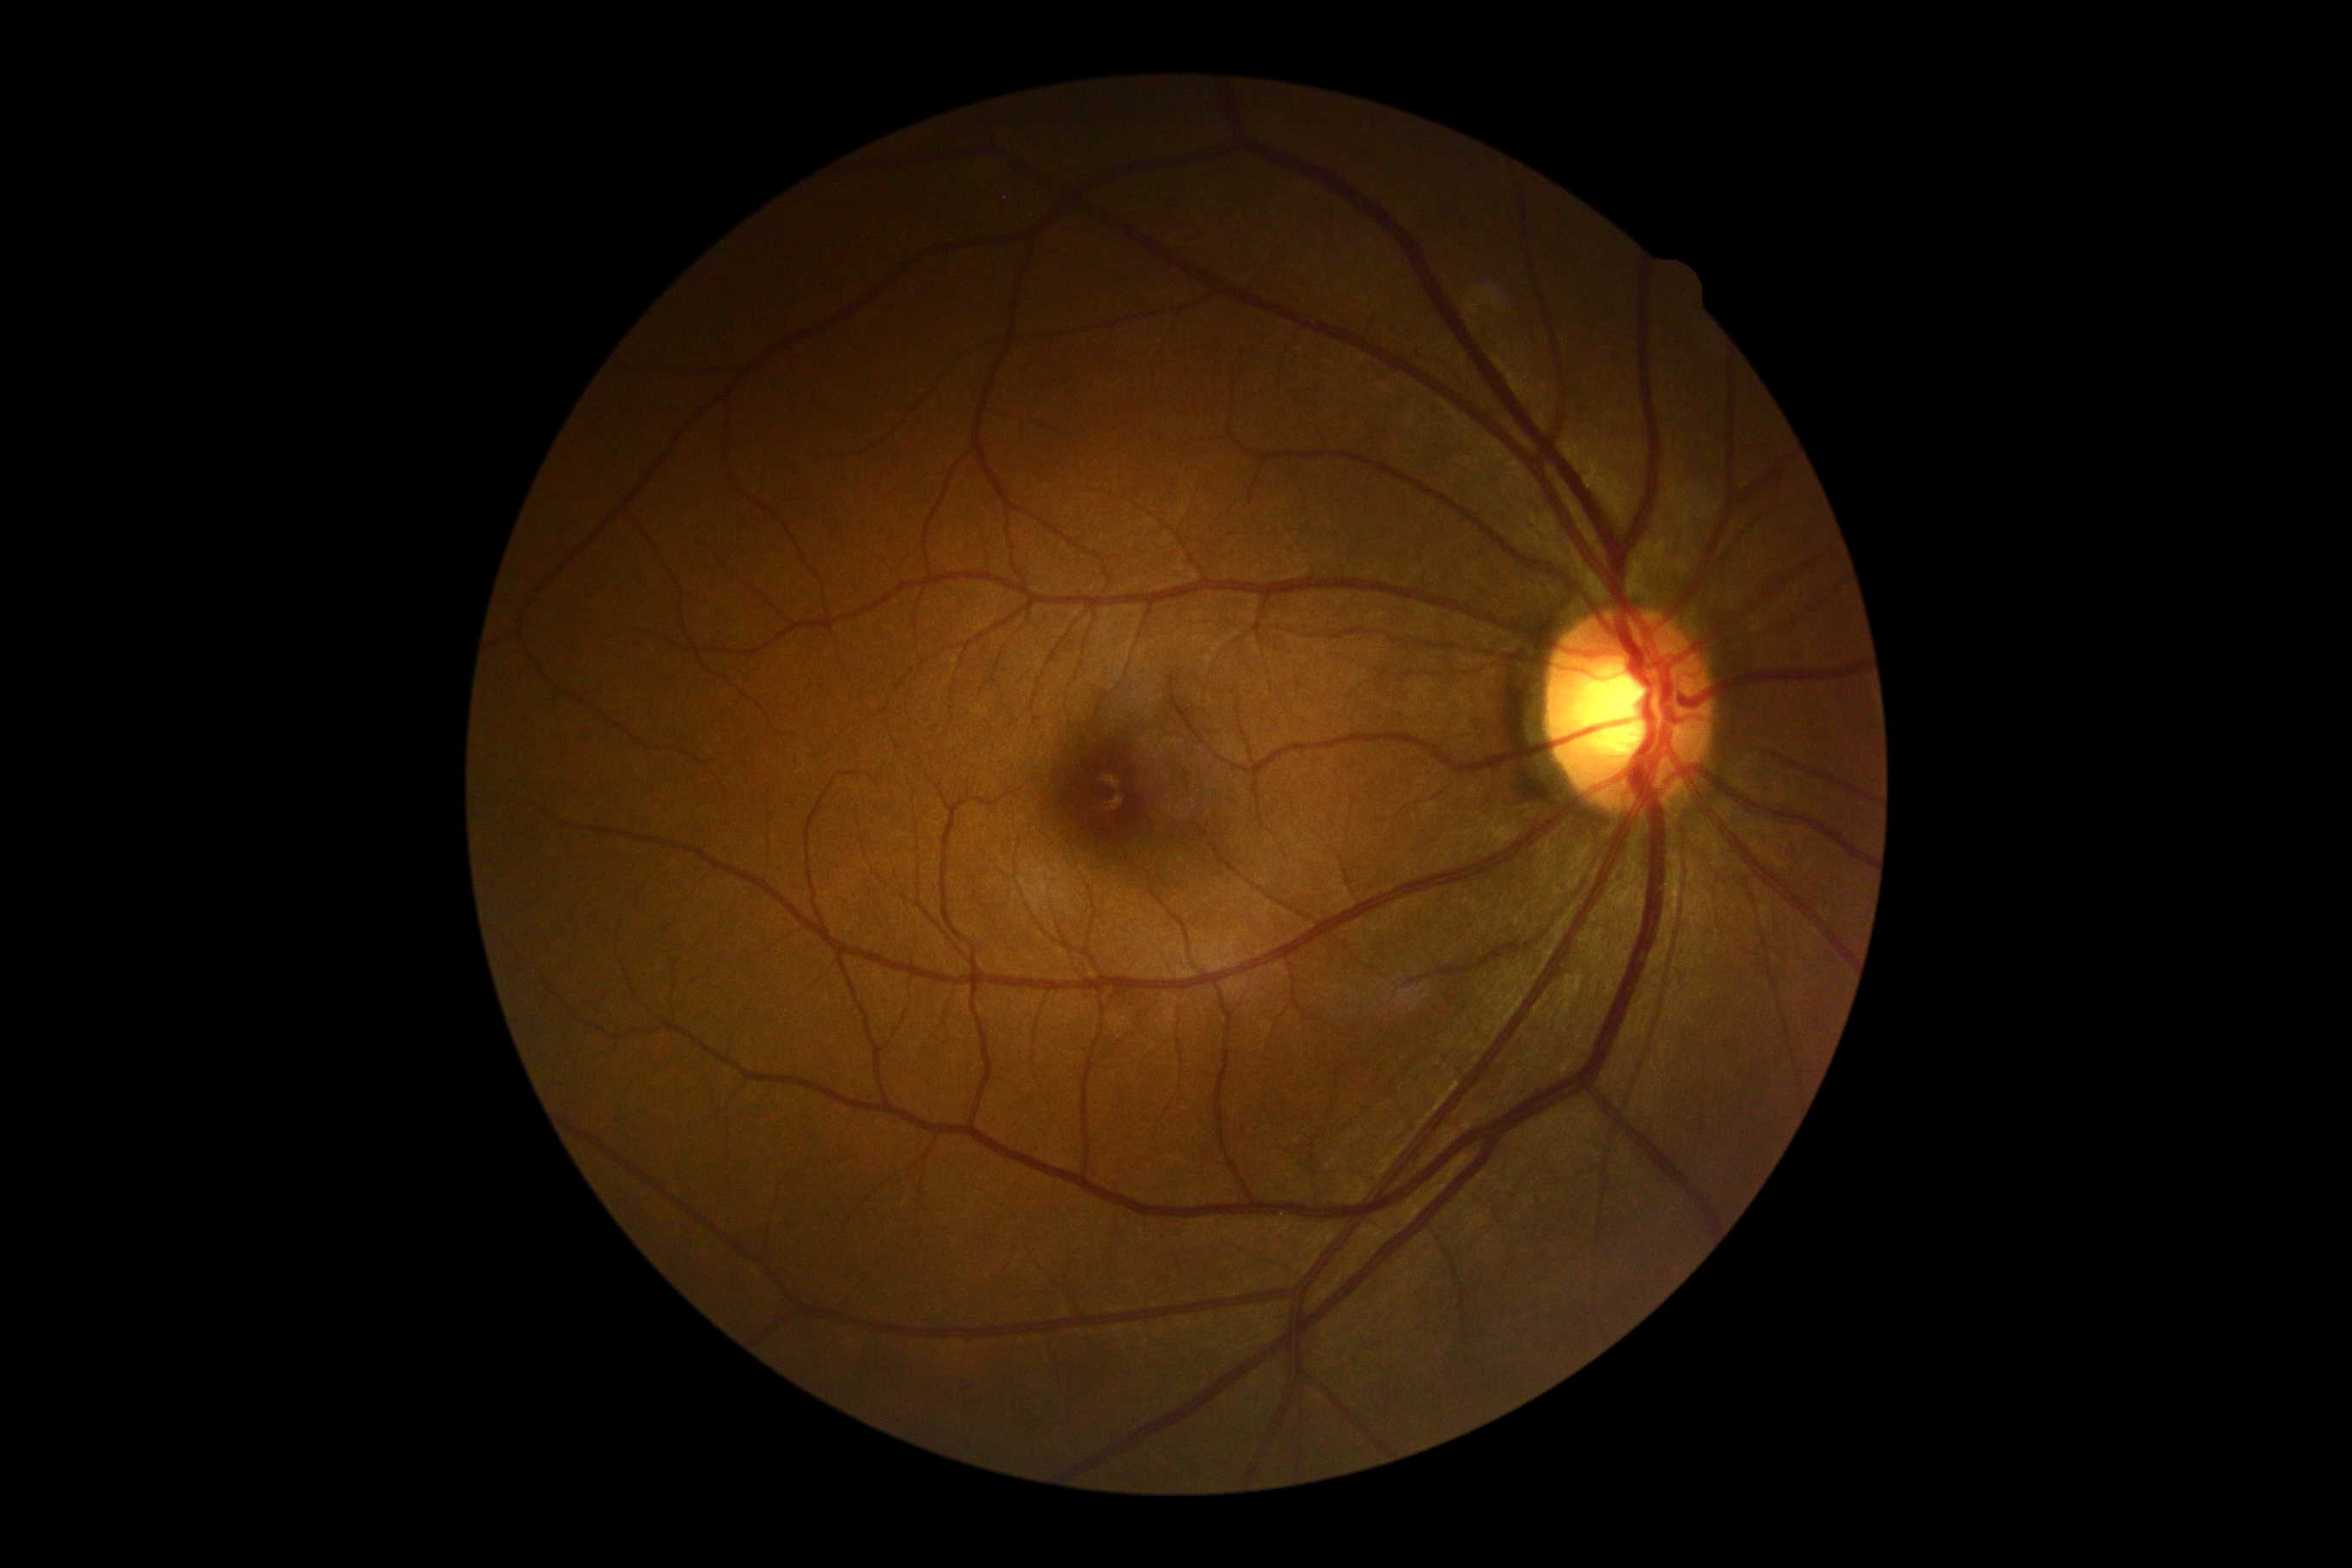

Diabetic retinopathy (DR): 0 — no visible signs of diabetic retinopathy.